FOV: 45 degrees. Posterior pole photograph. NIDEK AFC-230 fundus camera. 848 x 848 pixels. Graded on the modified Davis scale — 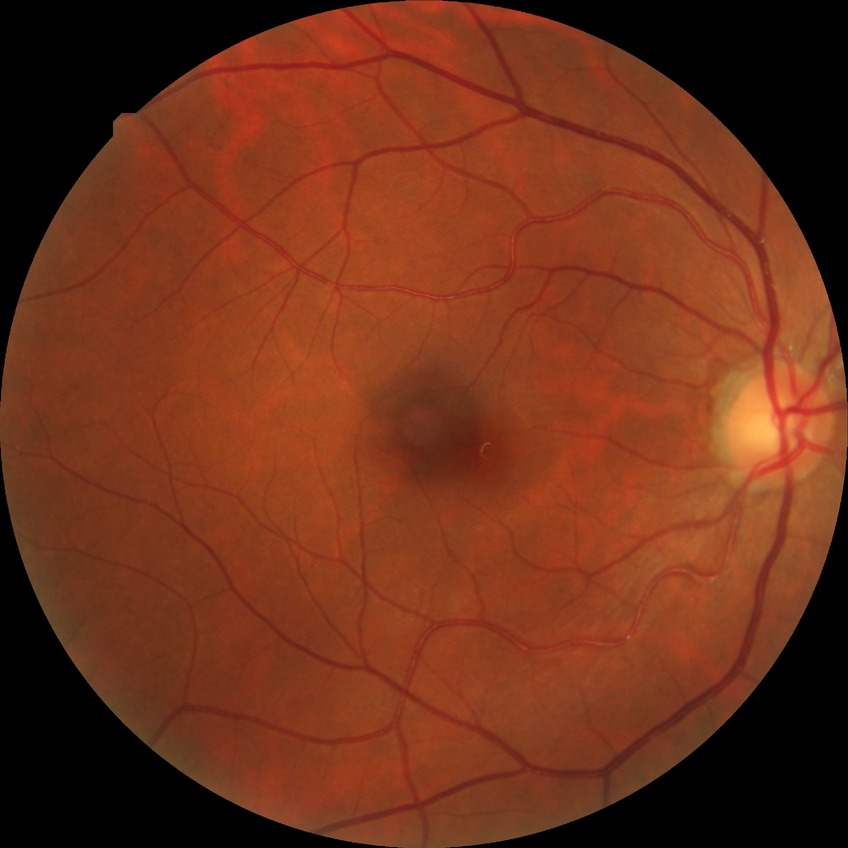

Assessment:
– retinopathy stage: no diabetic retinopathy